2048x1536px — 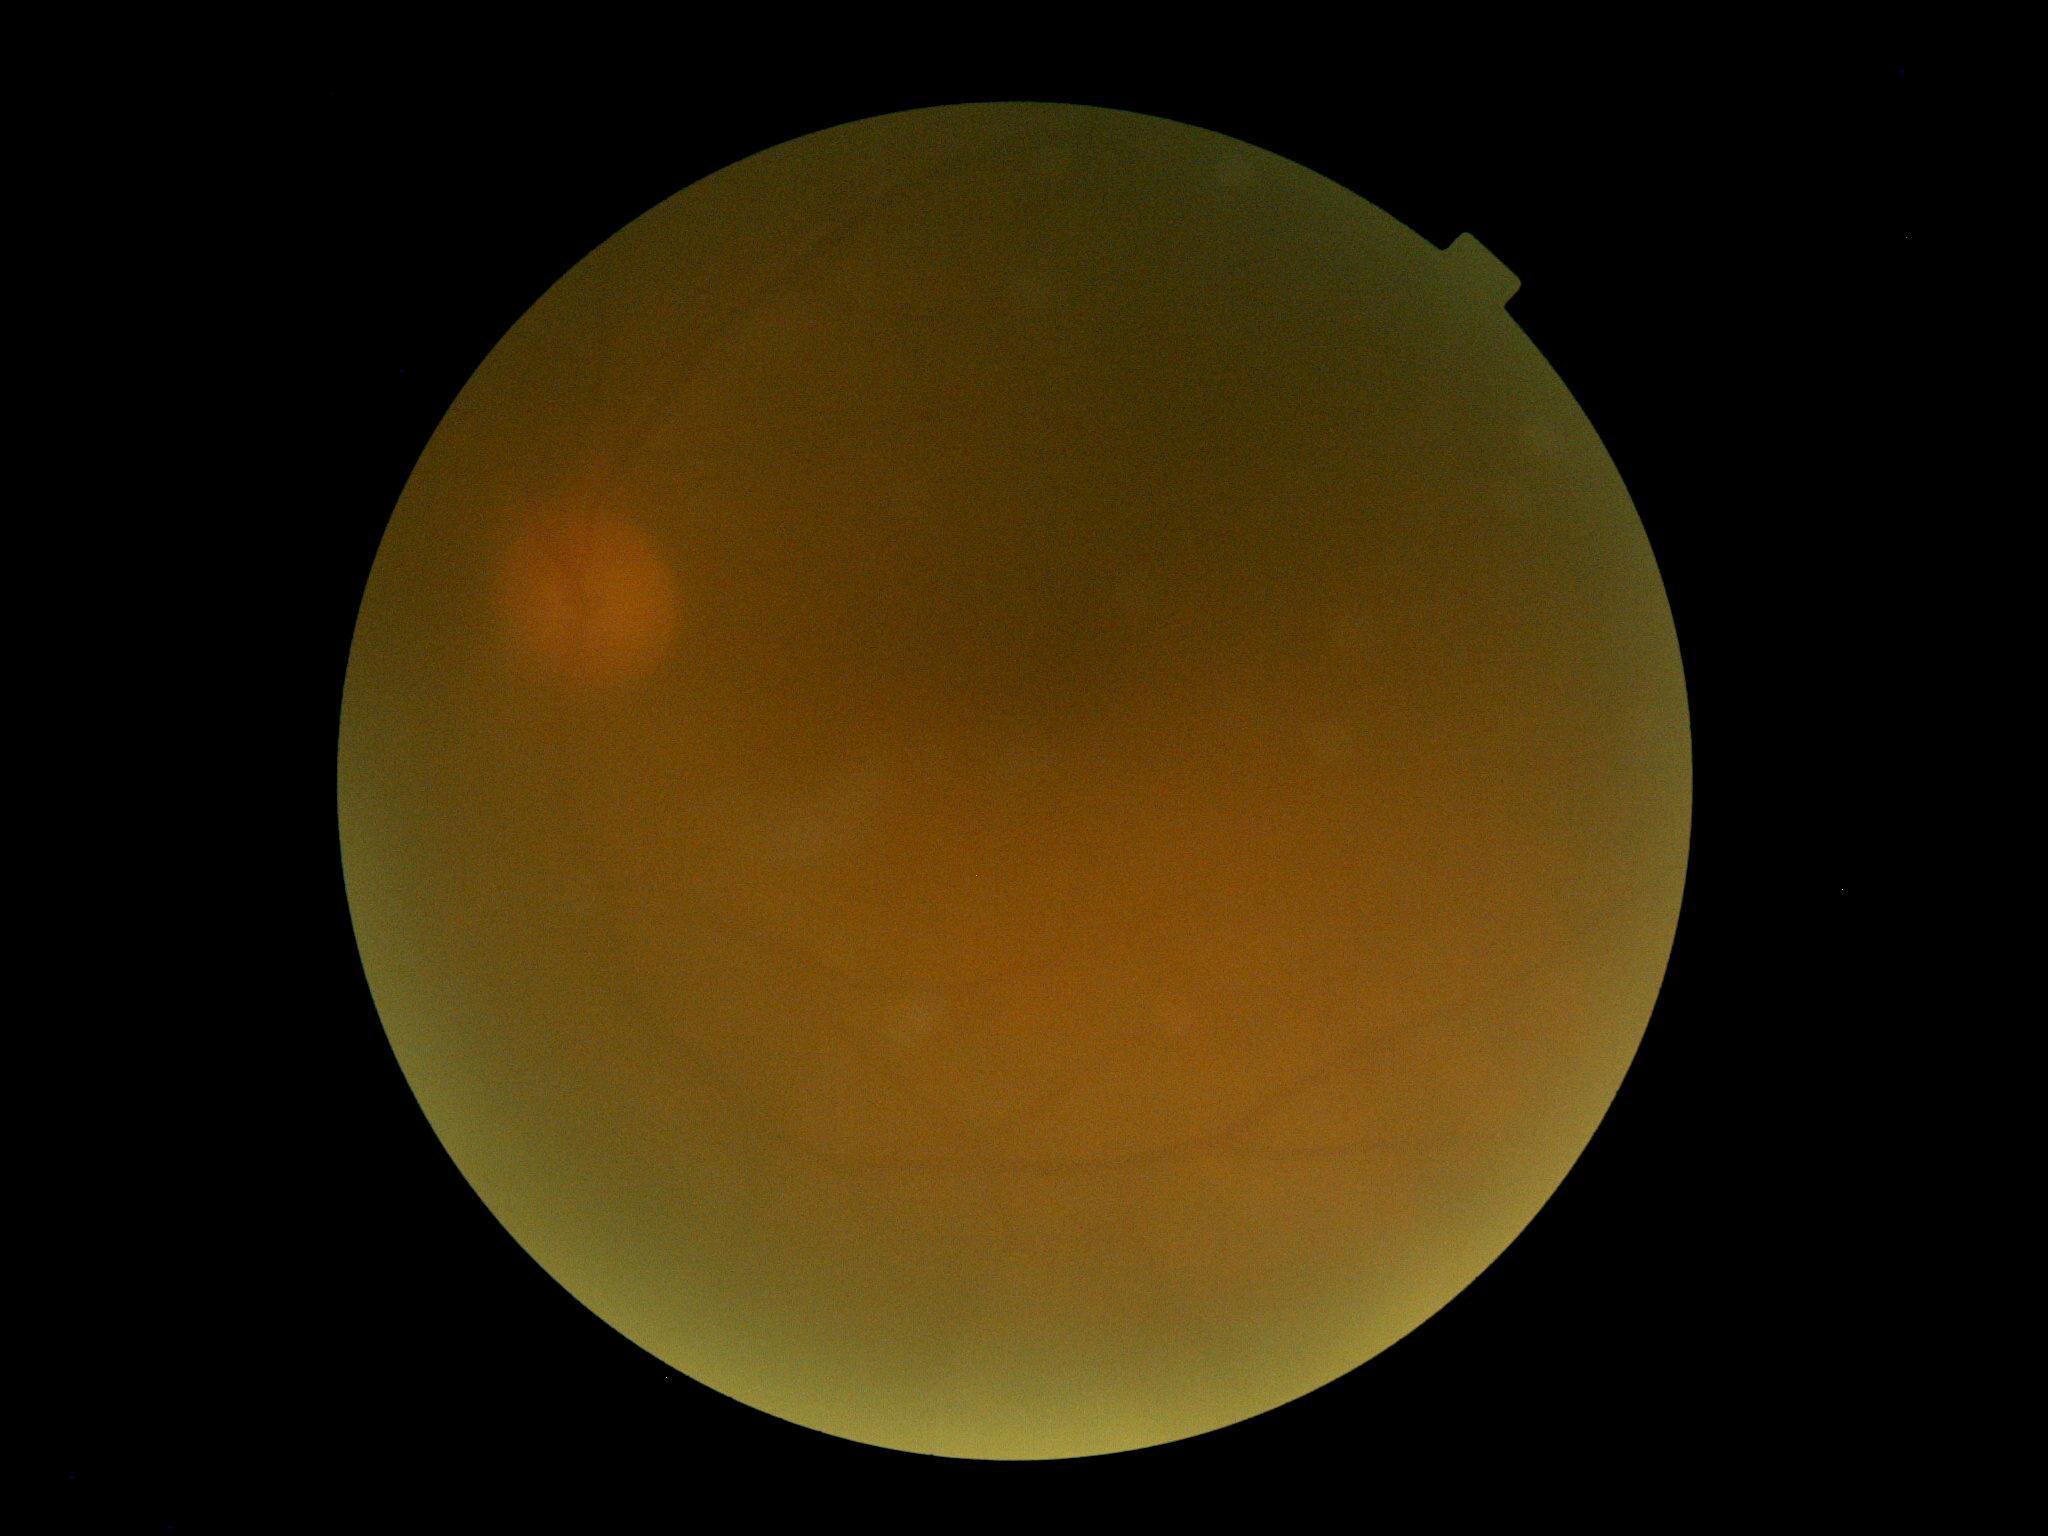
Image quality is insufficient for diabetic retinopathy assessment. Diabetic retinopathy (DR): ungradable due to poor image quality.